1240 by 1240 pixels; infant wide-field retinal image: 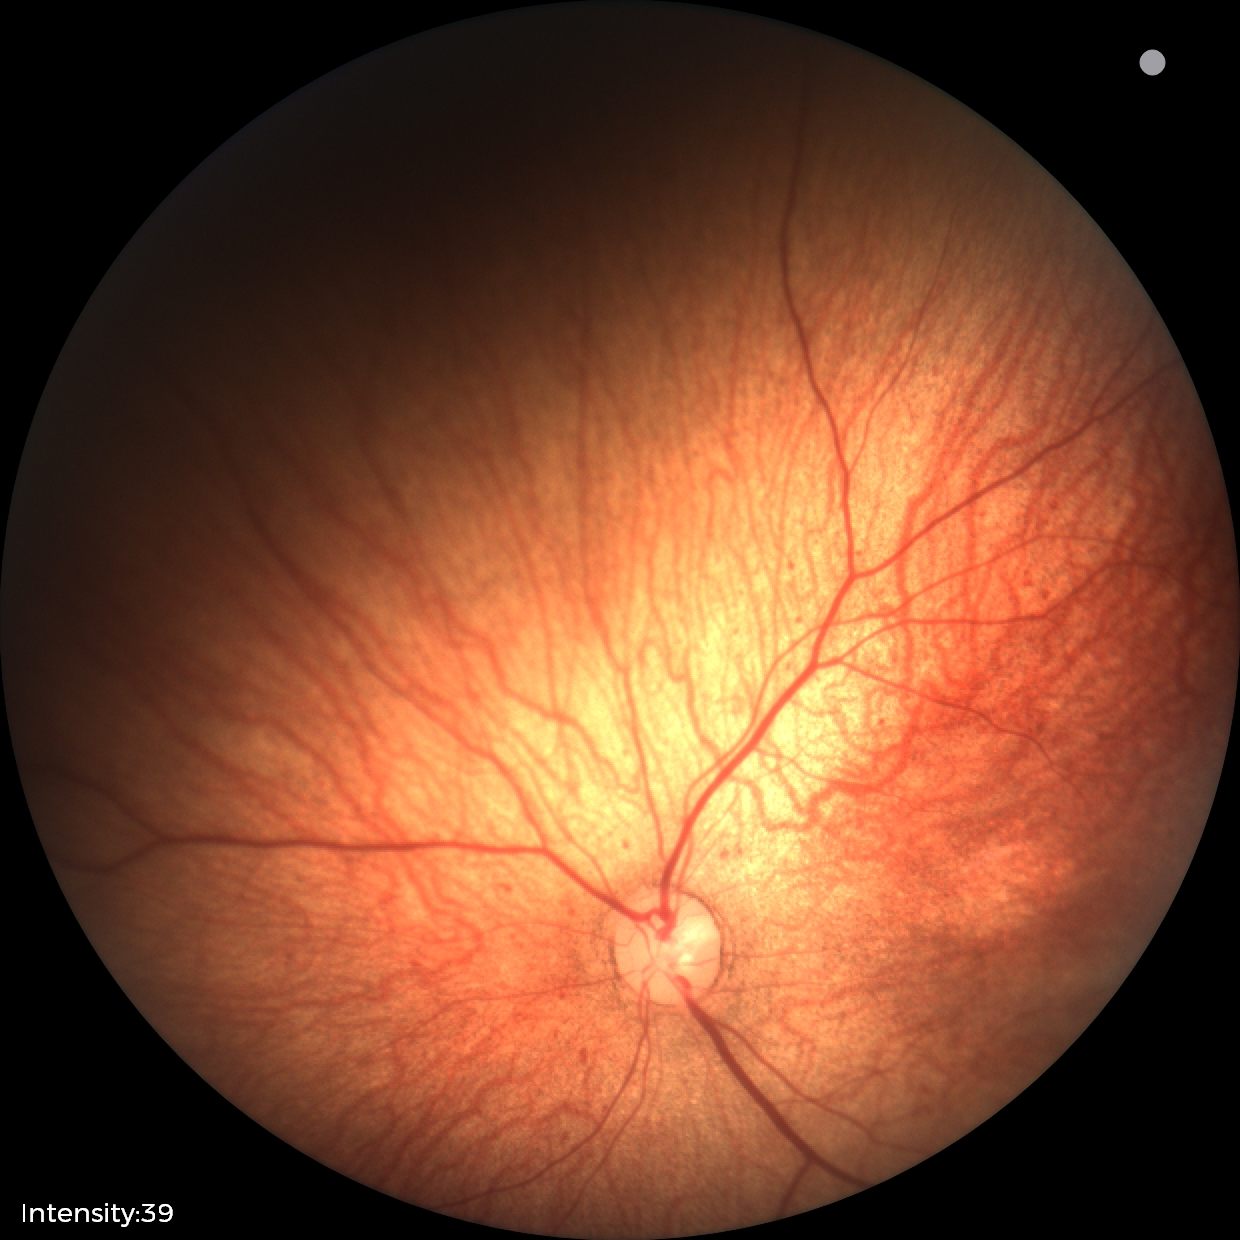

Assessment: normal retinal appearance.